Color fundus photograph:
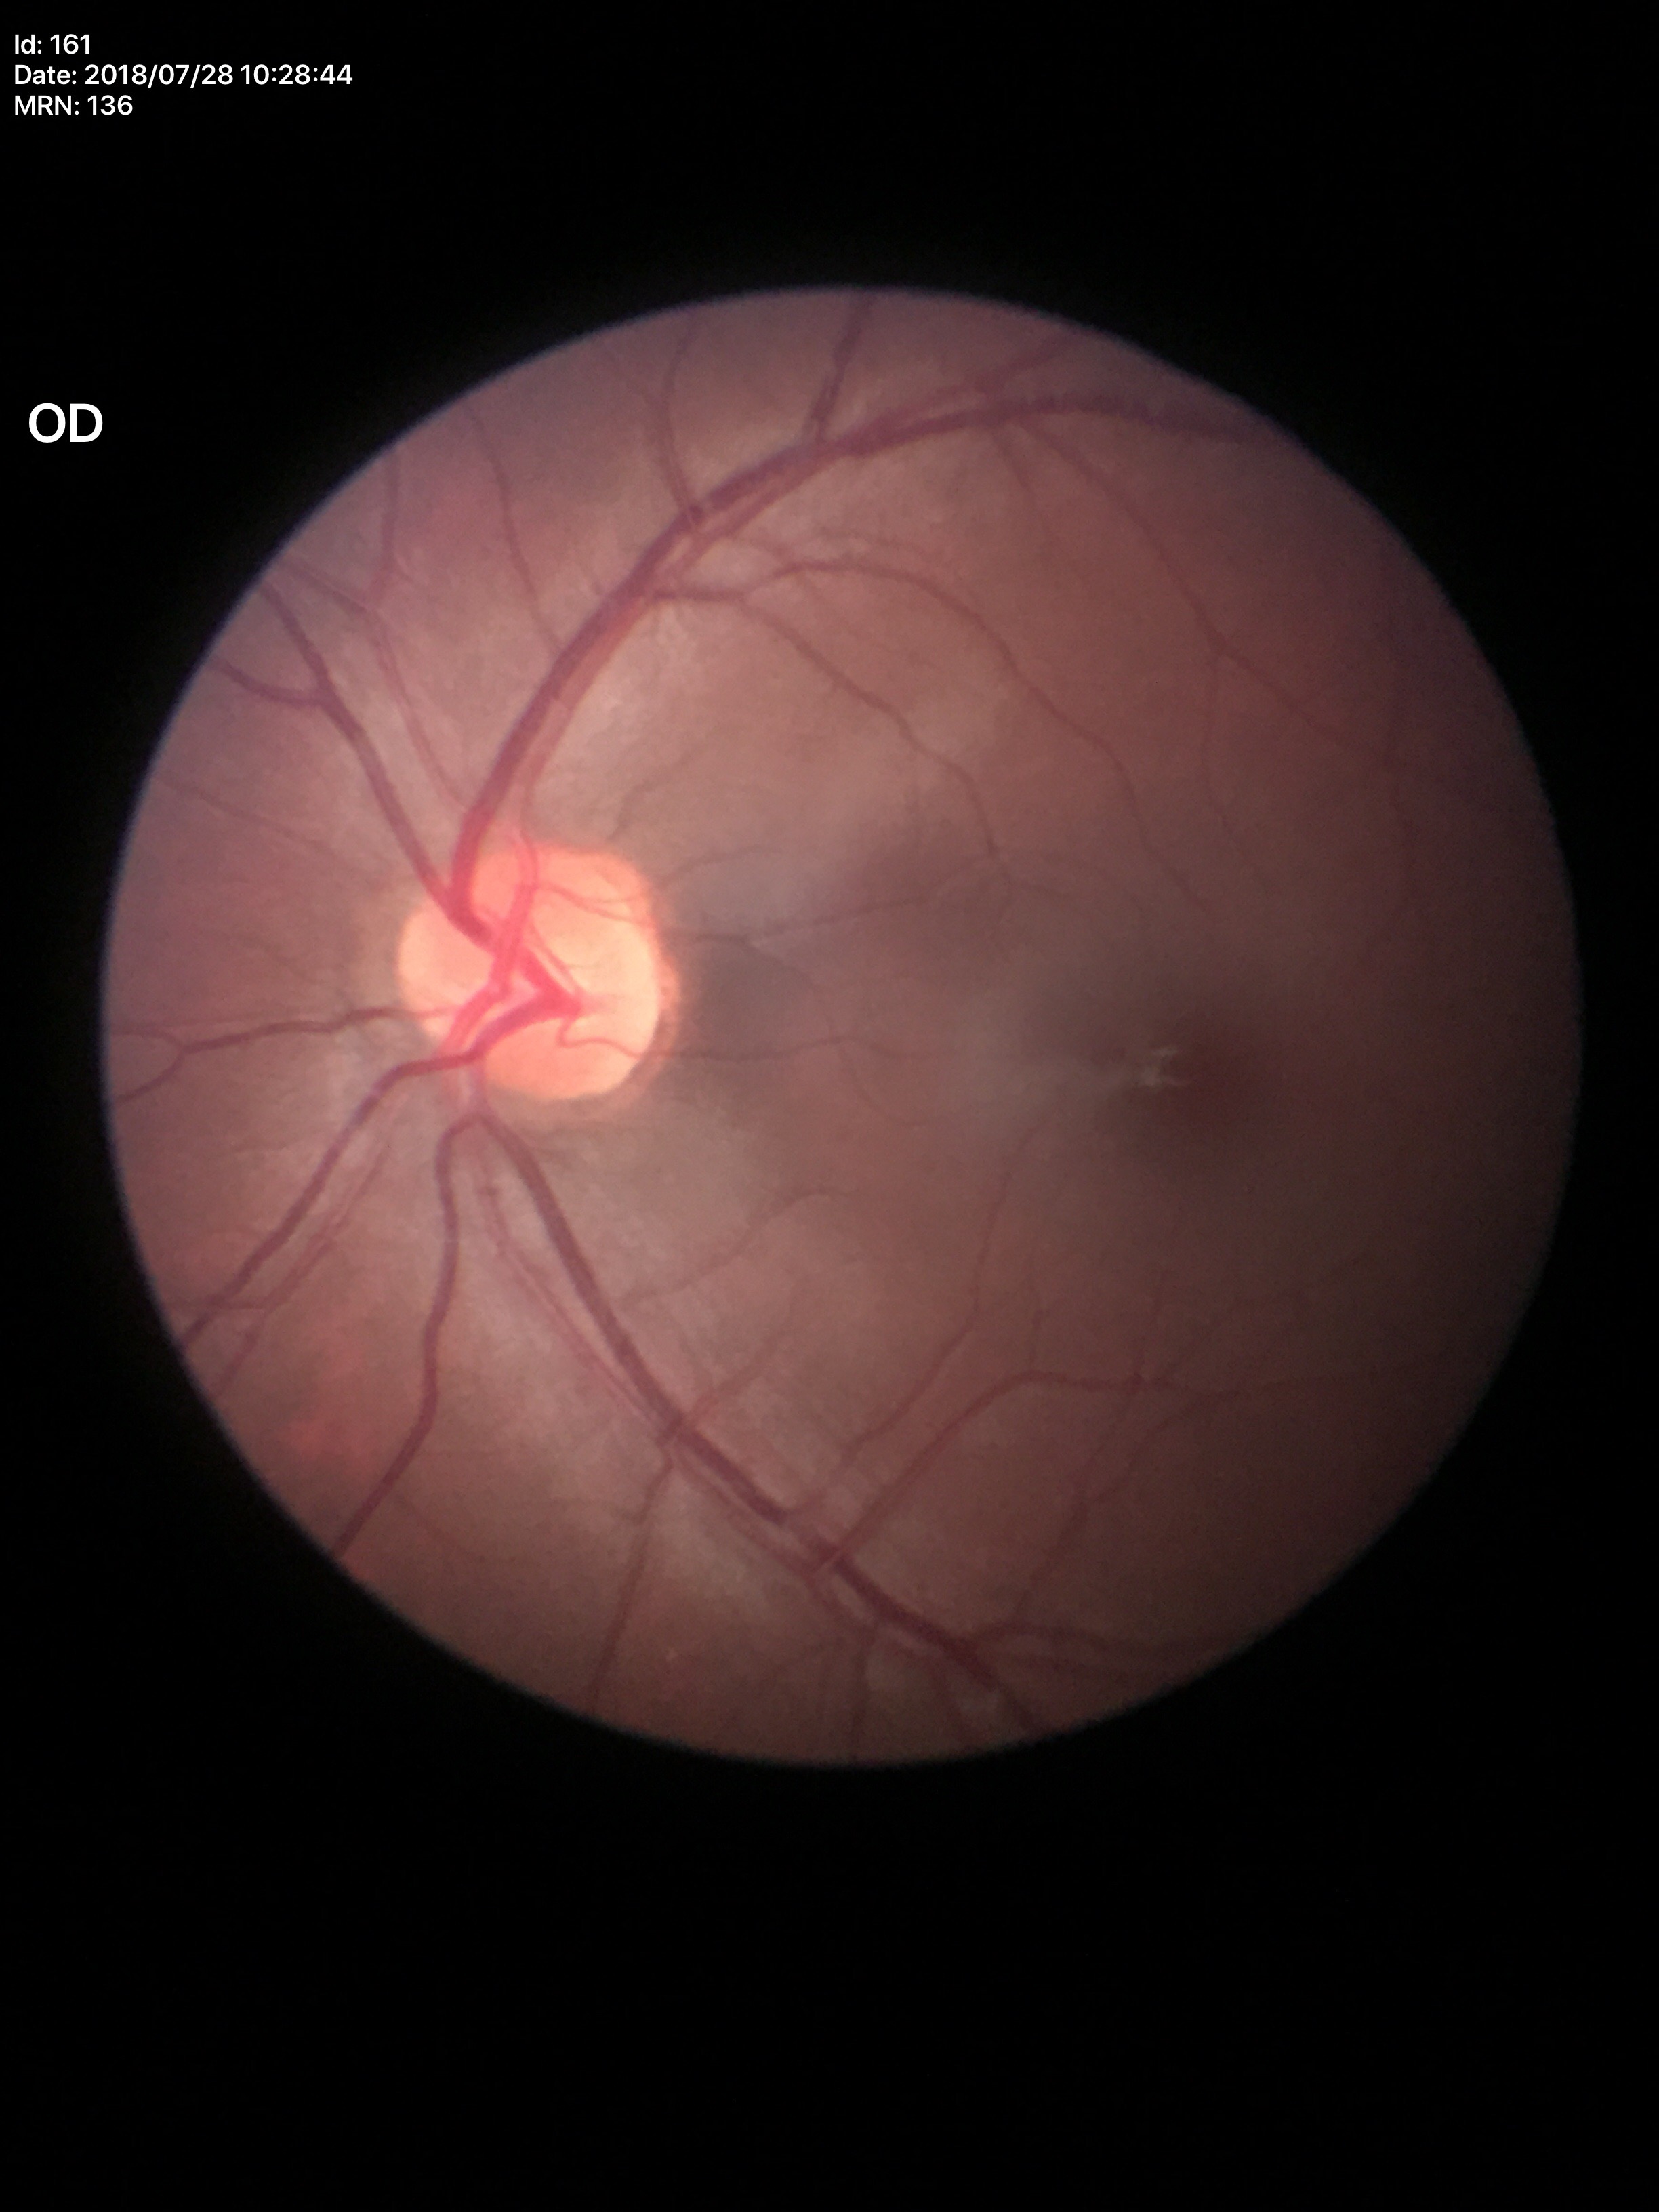 Glaucoma screening=no suspicious findings; VCDR=0.47